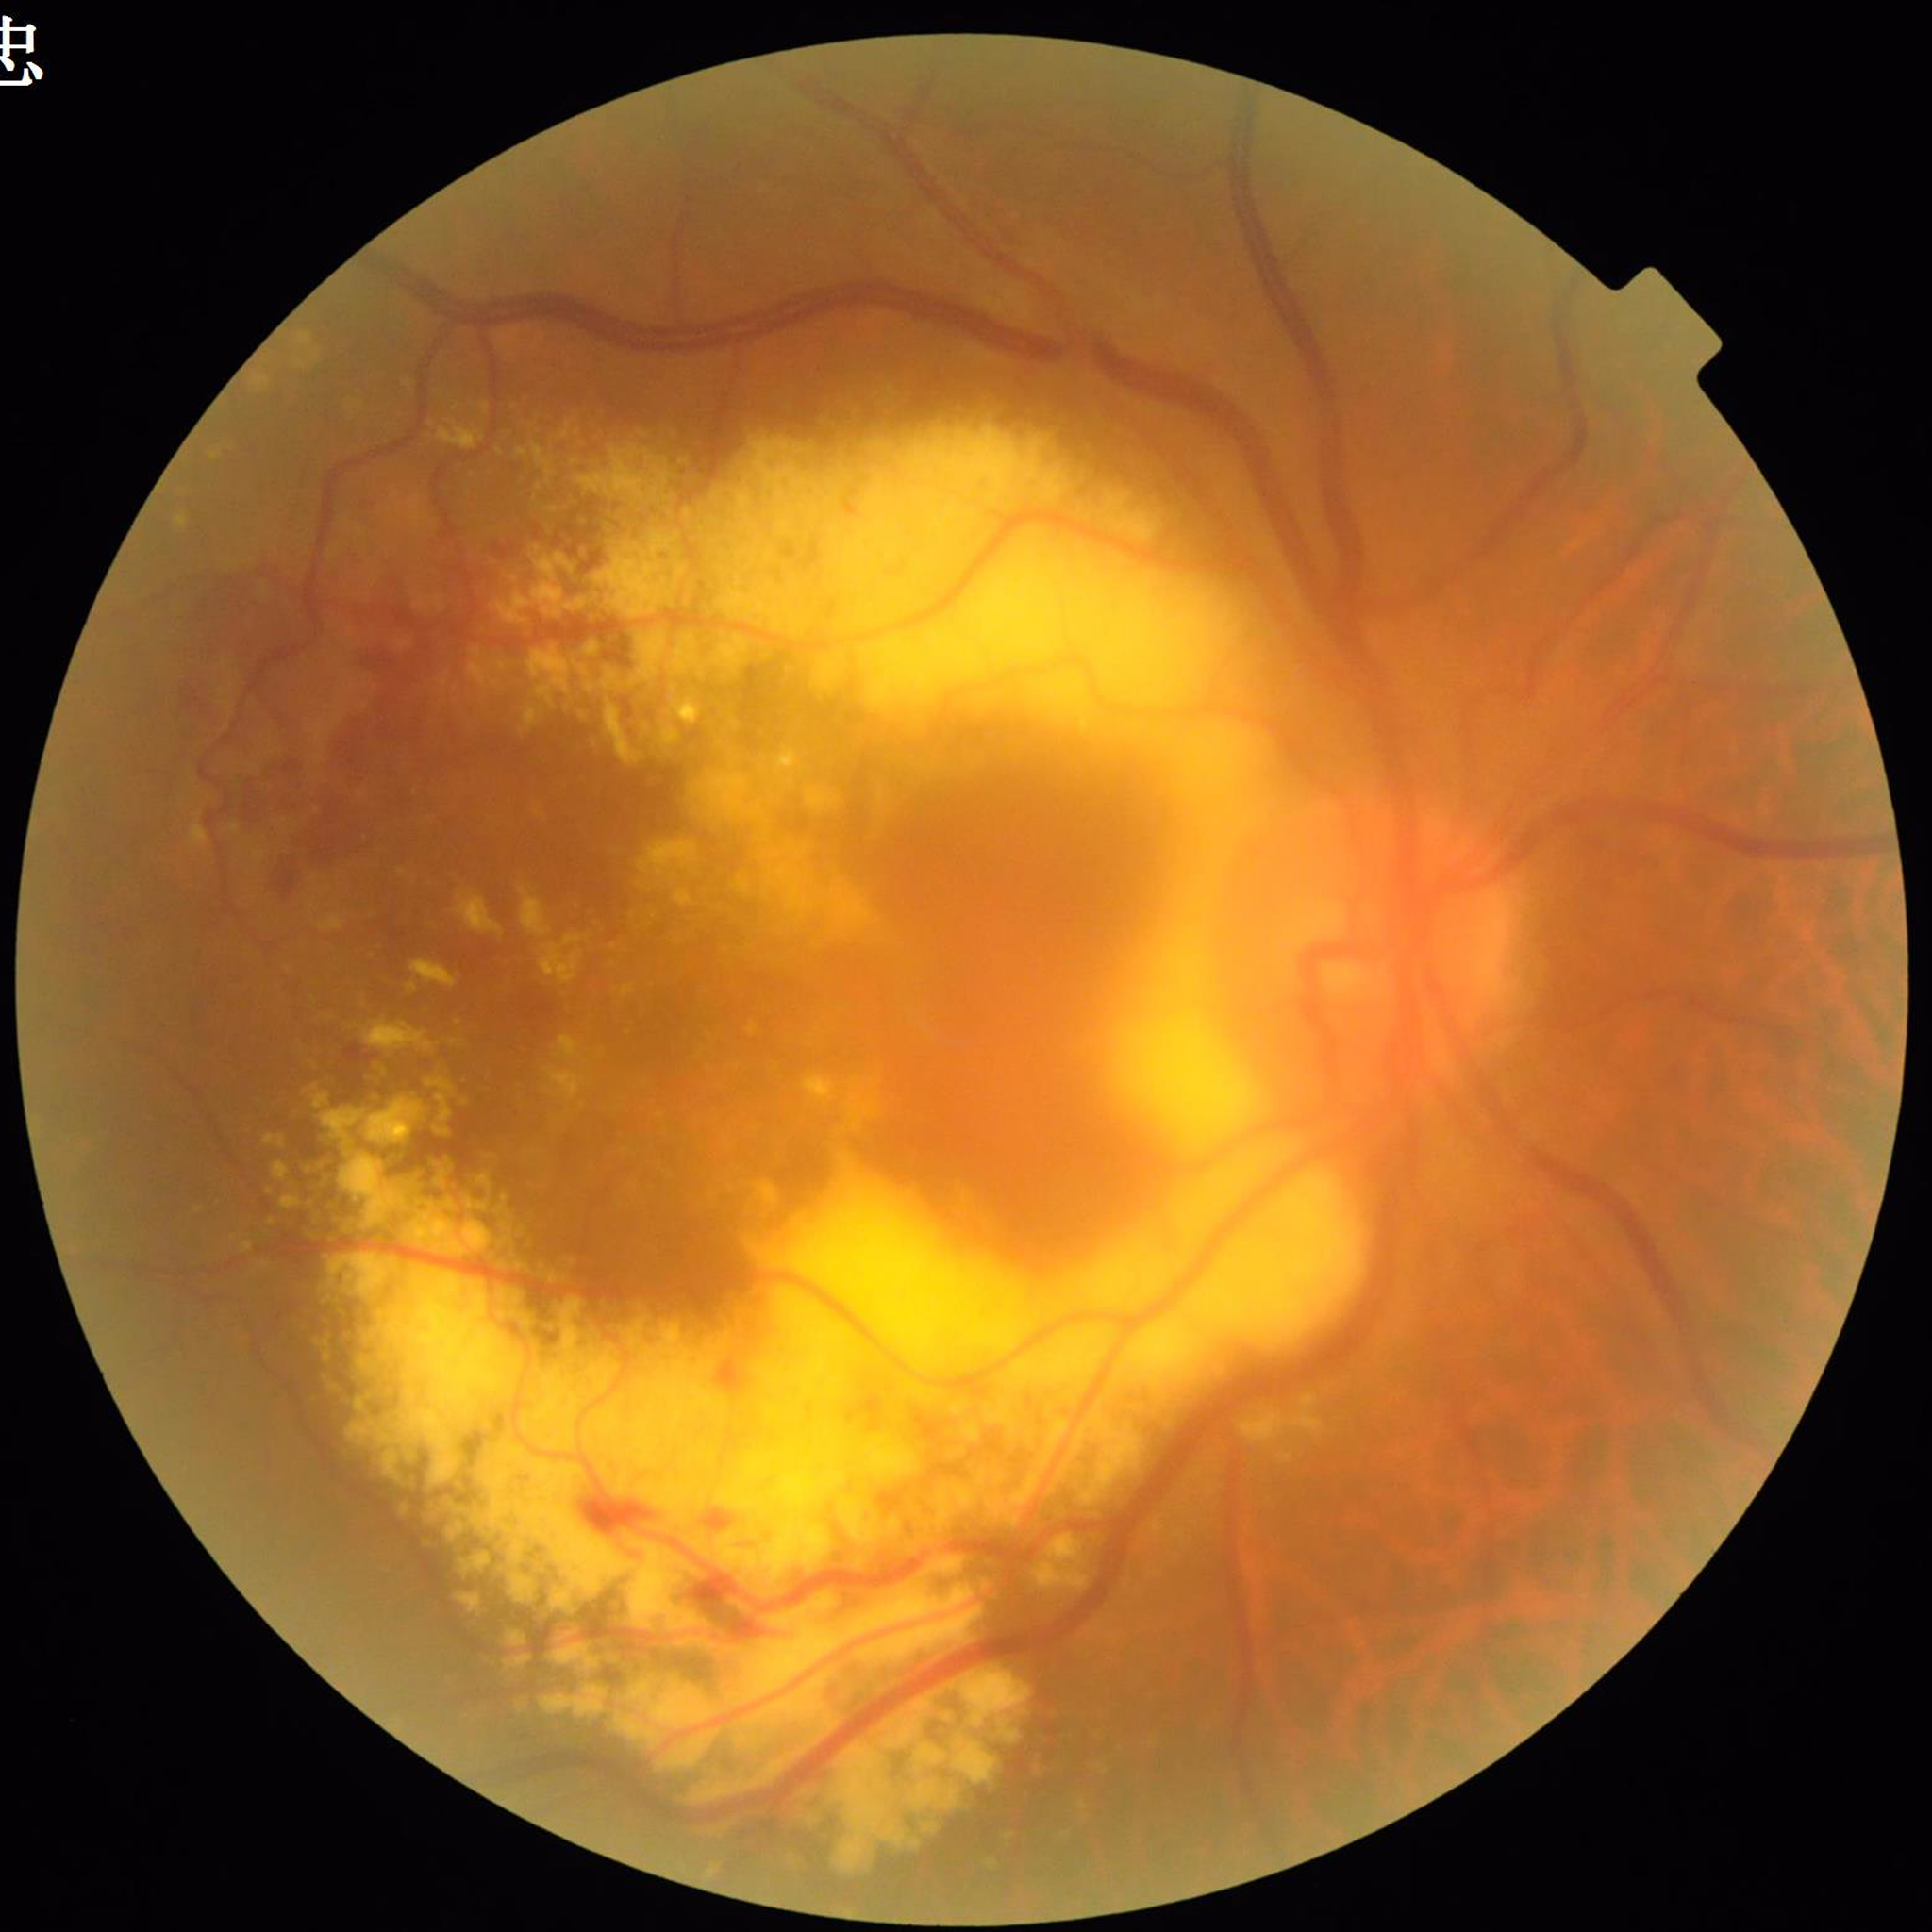 Image quality: issues noted — illumination/color distortion. The patient was diagnosed with AMD.